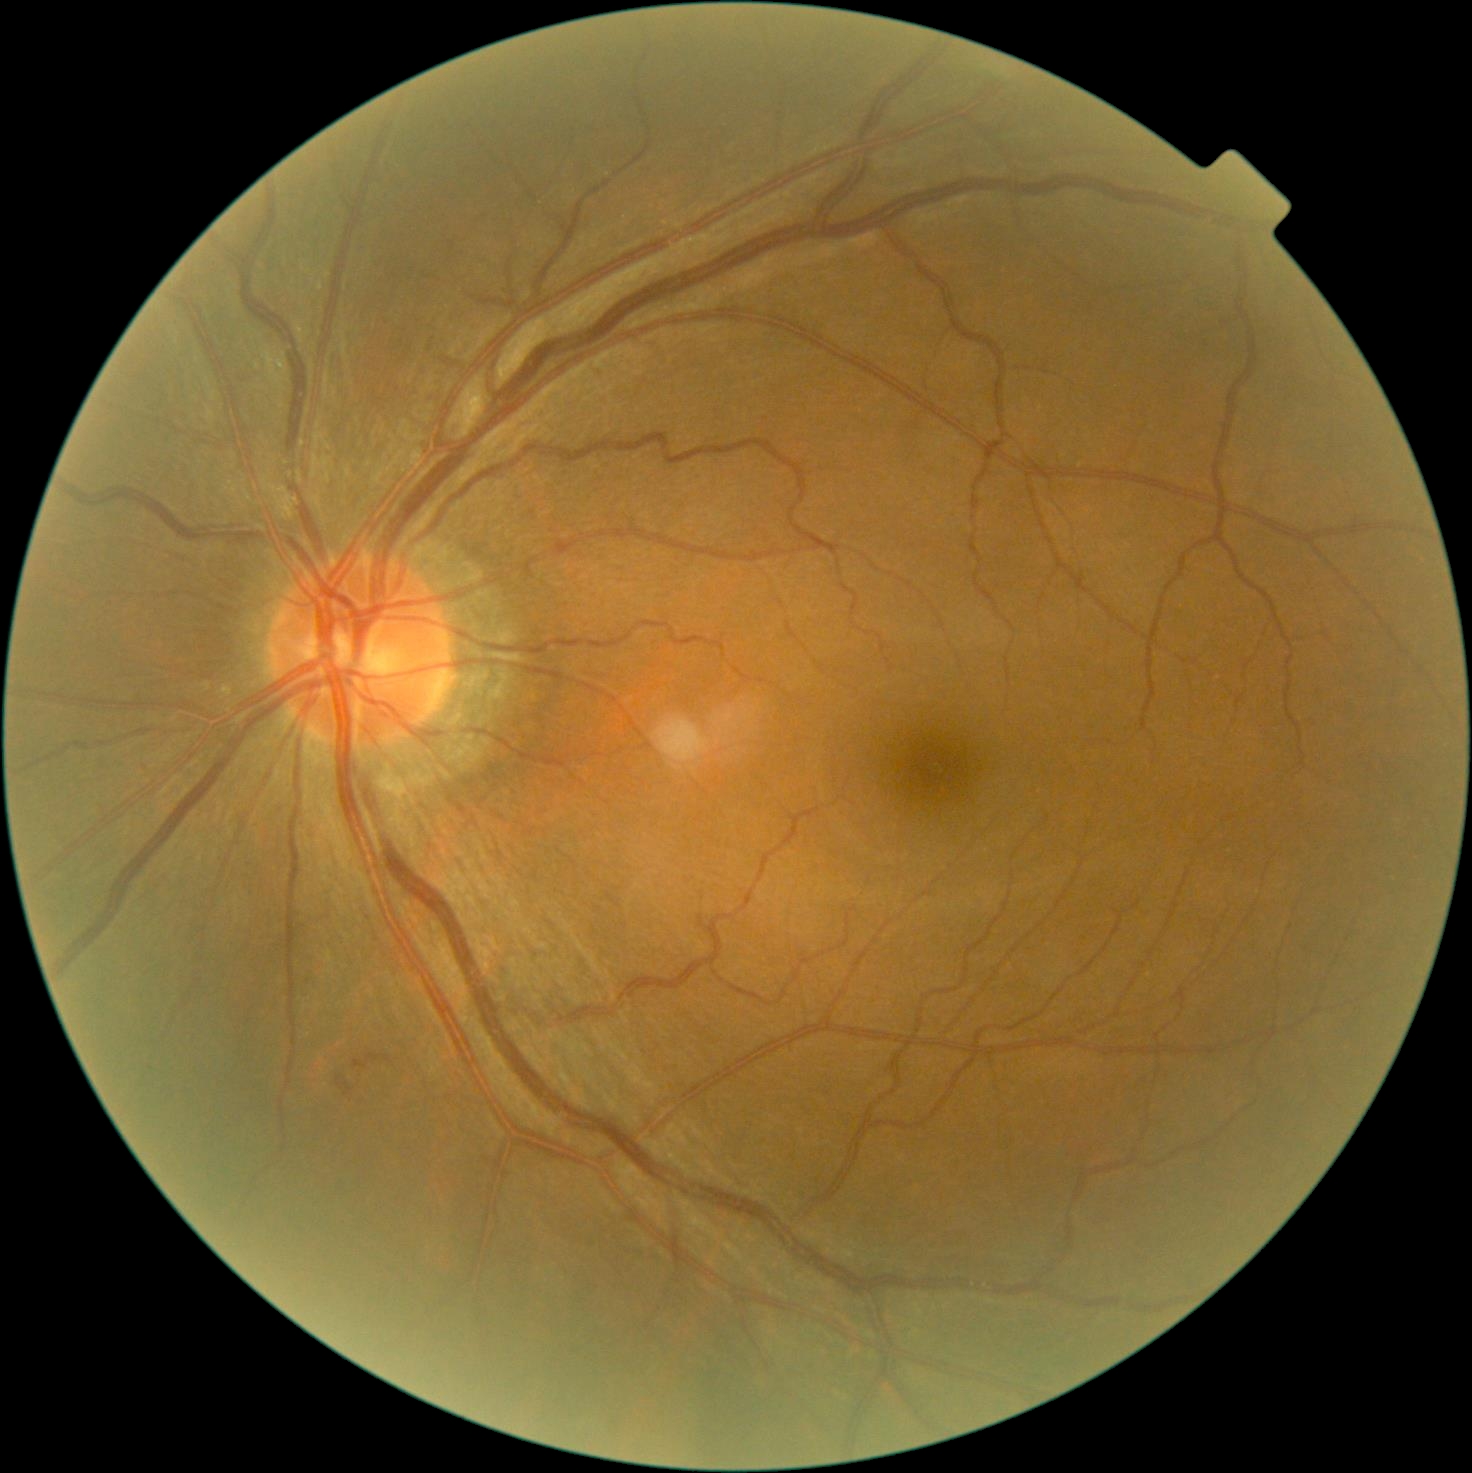 DR is moderate non-proliferative diabetic retinopathy (grade 2).